CFP:
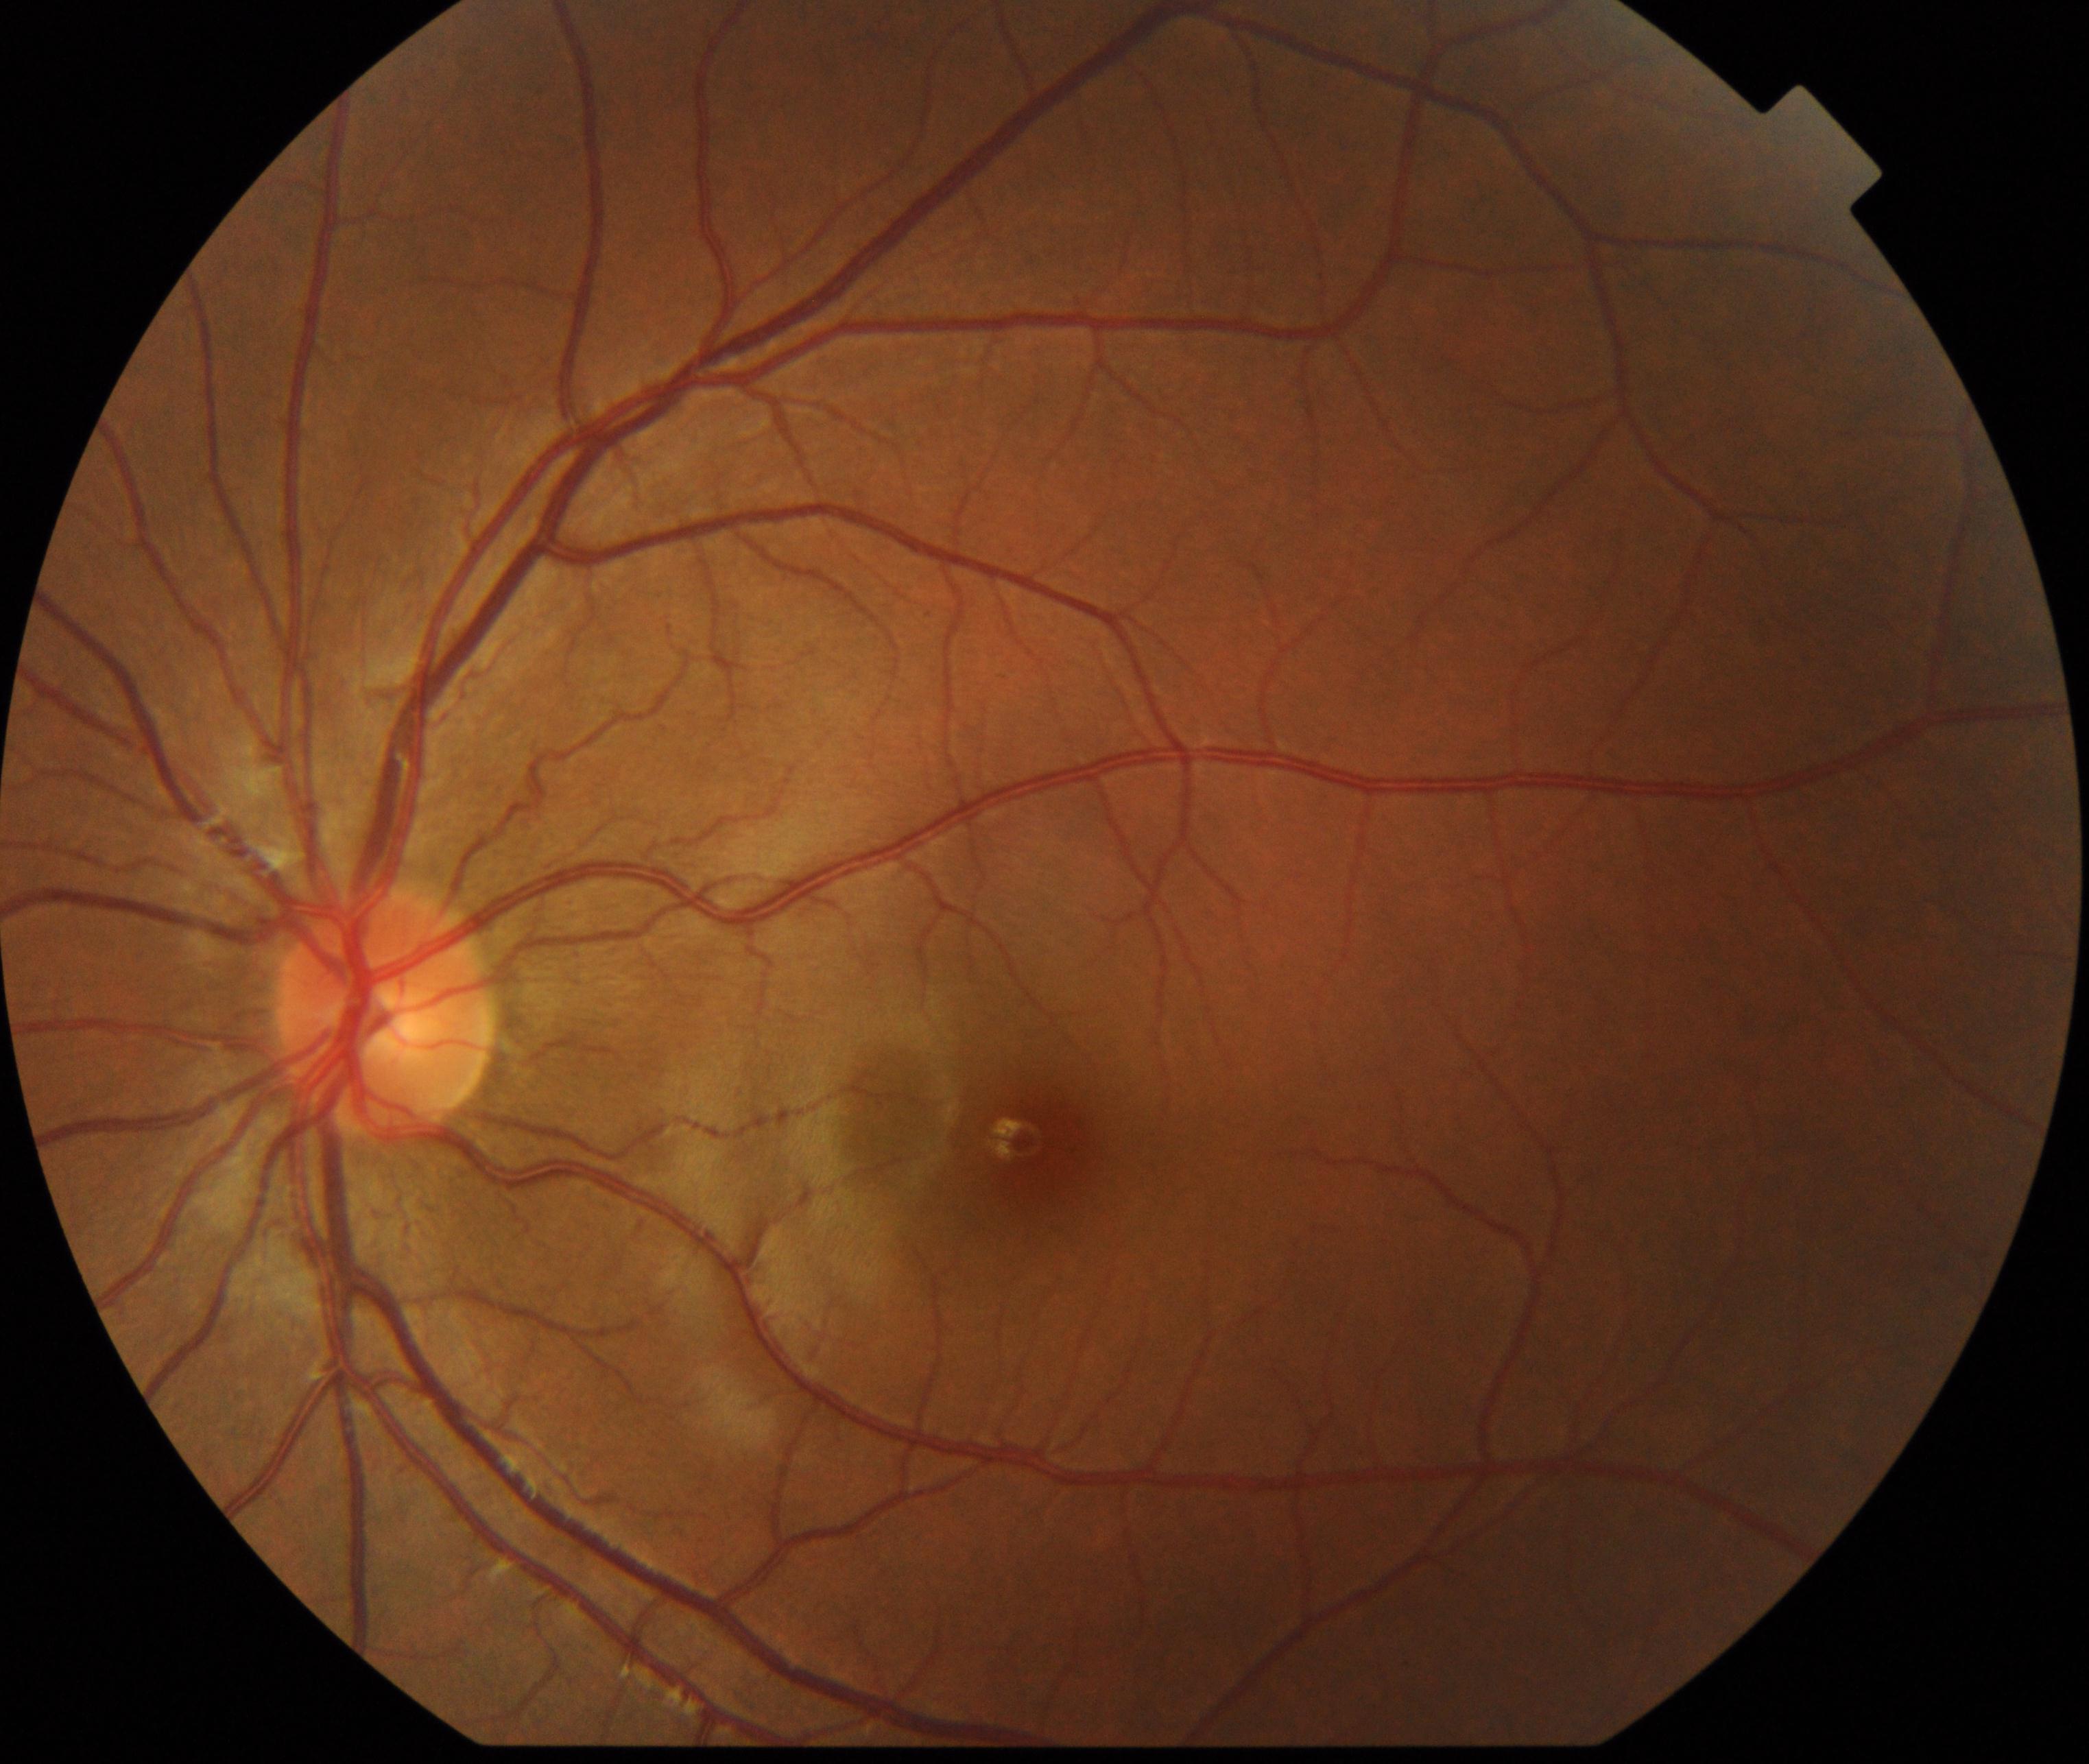
Normal fundus. No pathology identified.